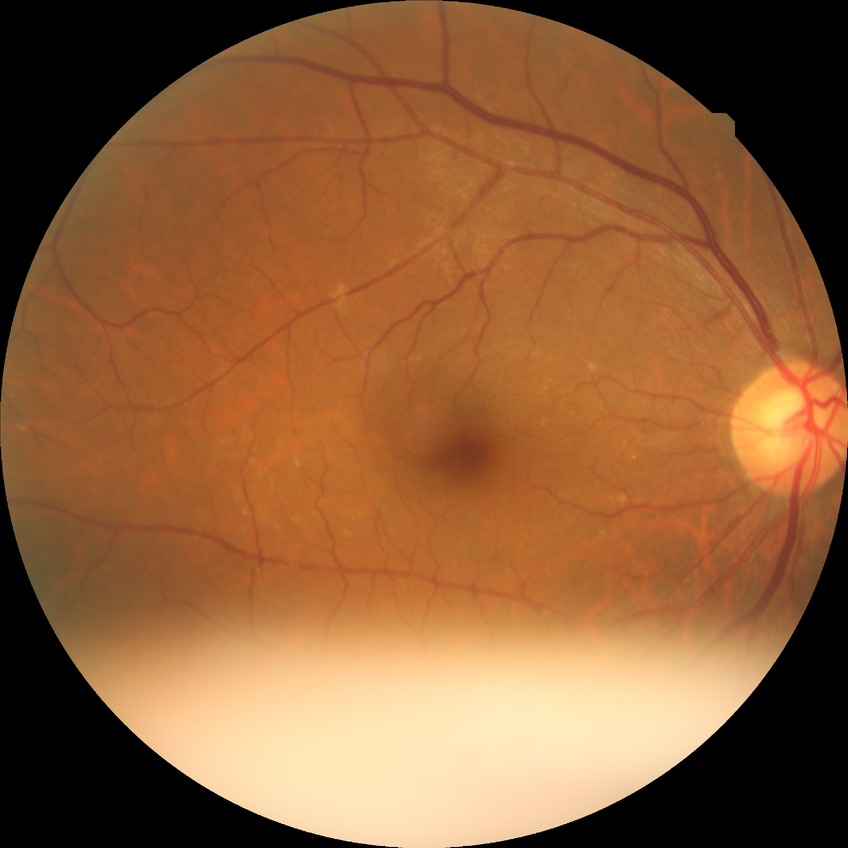
diabetic retinopathy grade@no diabetic retinopathy.